2048x1536px. Color fundus image. 45° FOV:
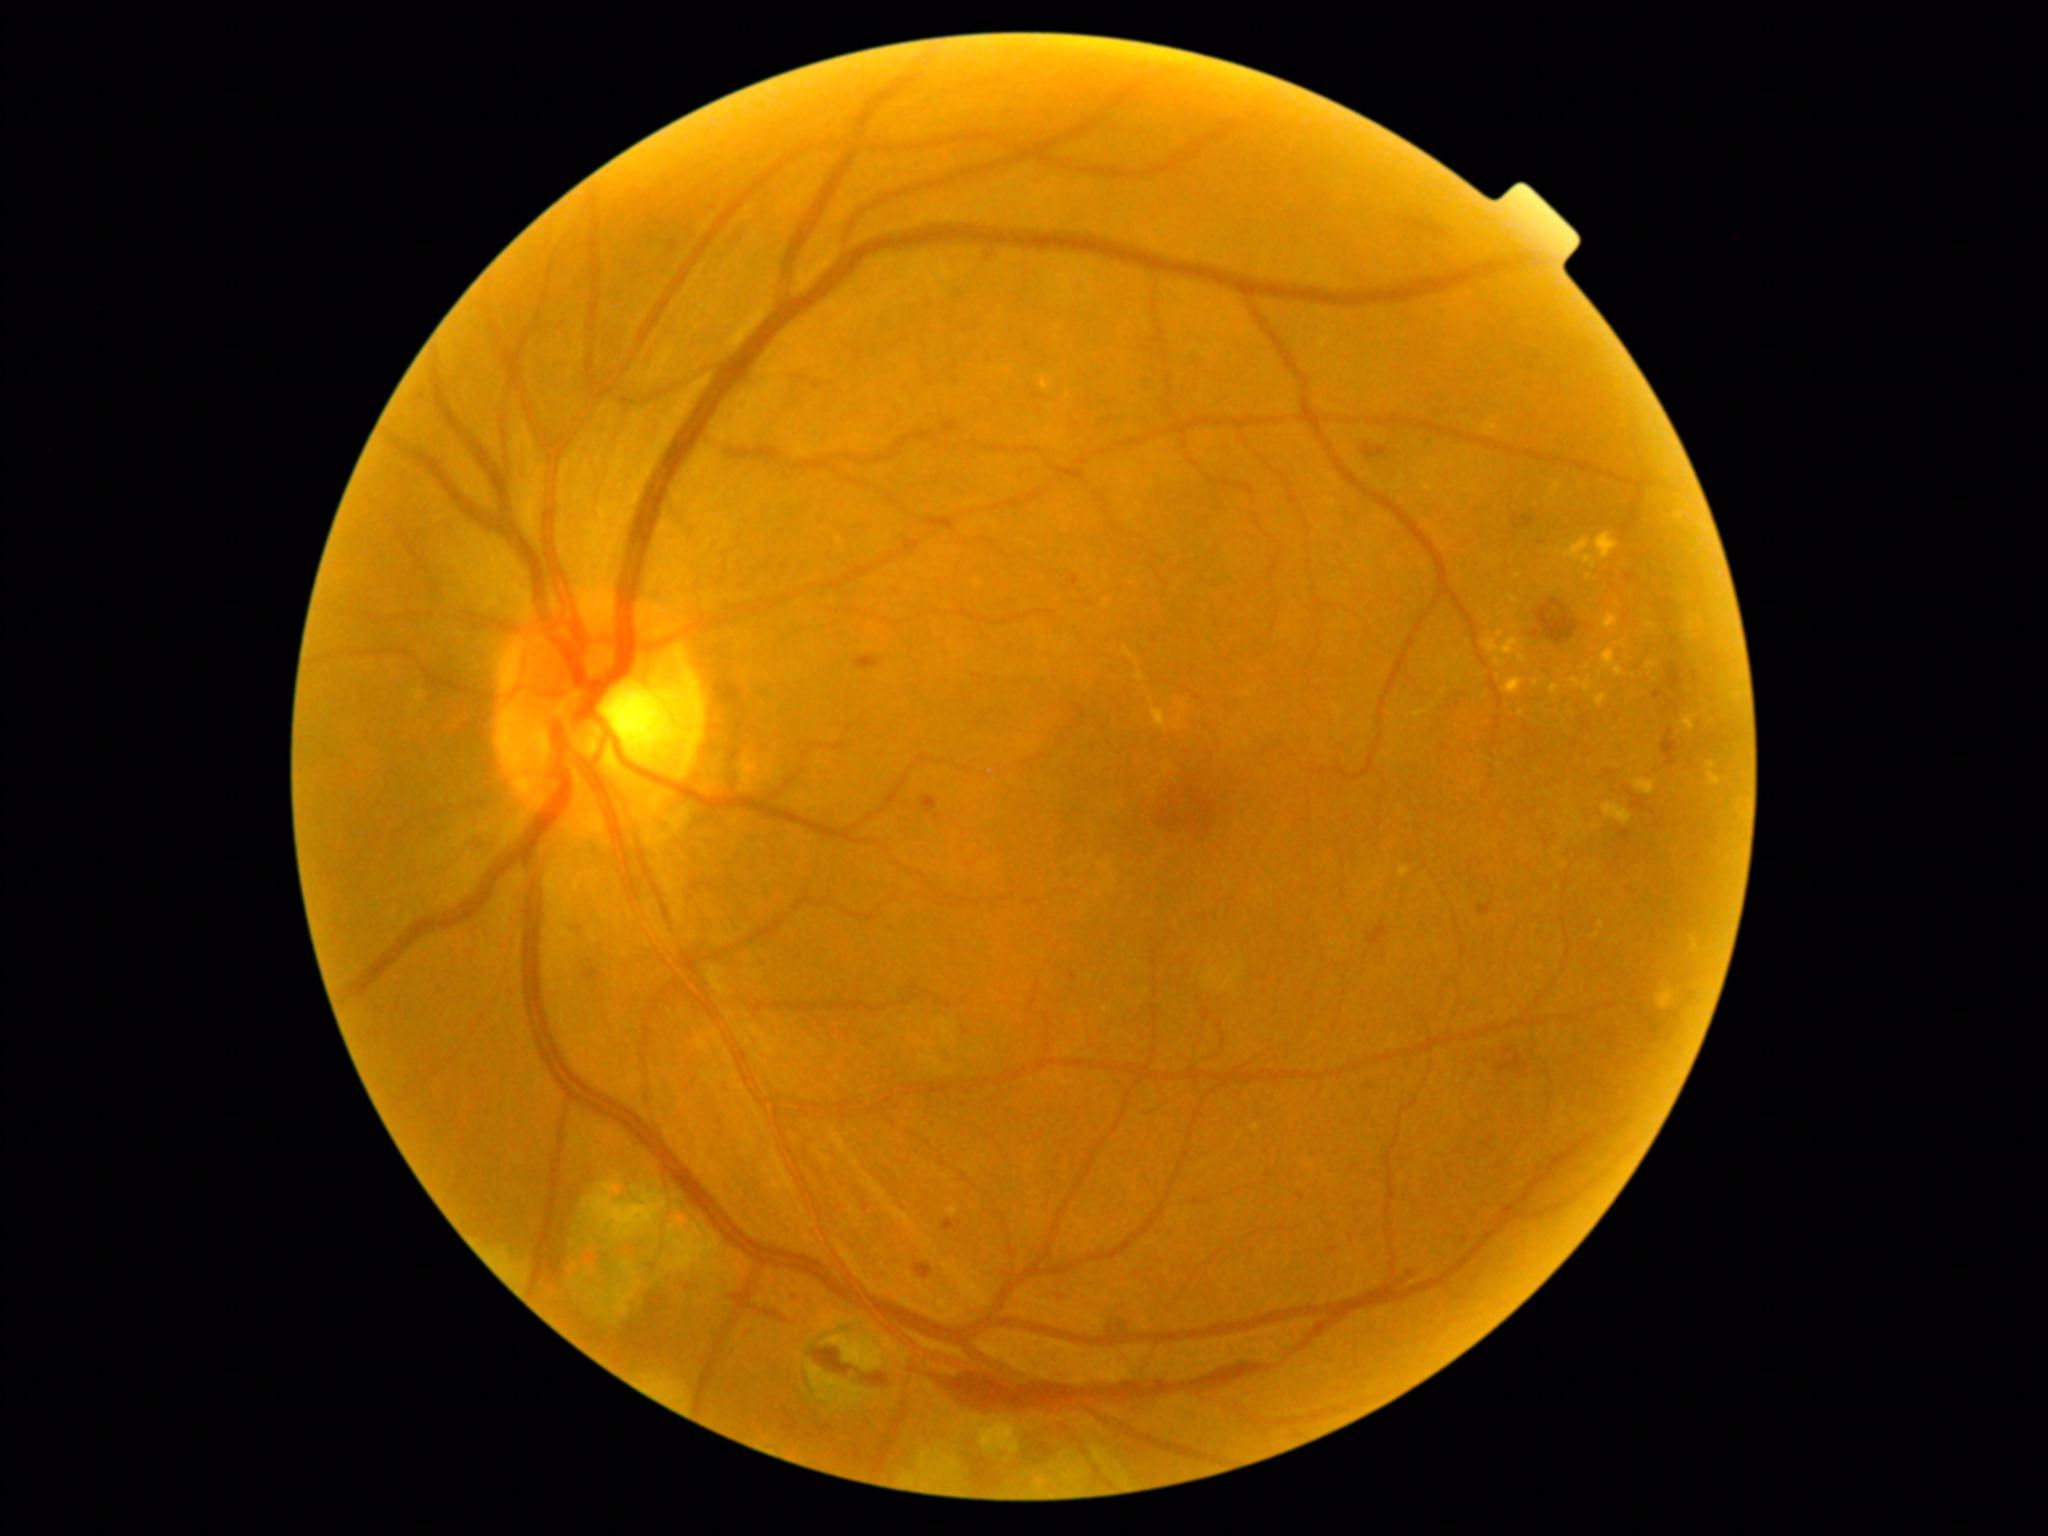
Retinopathy is grade 2 (moderate NPDR)
Selected lesions:
microaneurysms: (1298, 1193, 1305, 1201) | (942, 1220, 962, 1232) | (1621, 830, 1631, 839) | (1070, 971, 1077, 981) | (1463, 1237, 1470, 1245)
Additional small microaneurysms near <pt>1661,695</pt> | <pt>797,1295</pt> | <pt>752,1332</pt> | <pt>1077,579</pt> | <pt>939,818</pt> | <pt>1155,638</pt>
hemorrhages (more not shown): (921, 796, 938, 812) | (855, 655, 881, 671) | (730, 1293, 787, 1321) | (931, 1308, 1357, 1417) | (1625, 573, 1638, 582) | (1625, 789, 1647, 810) | (585, 969, 602, 981) | (862, 1373, 889, 1386) | (1496, 1047, 1528, 1074) | (1532, 631, 1541, 638) | (1654, 691, 1681, 711) | (915, 1263, 934, 1279)
hard exudates: none detected
soft exudates: none detected